Color fundus image.
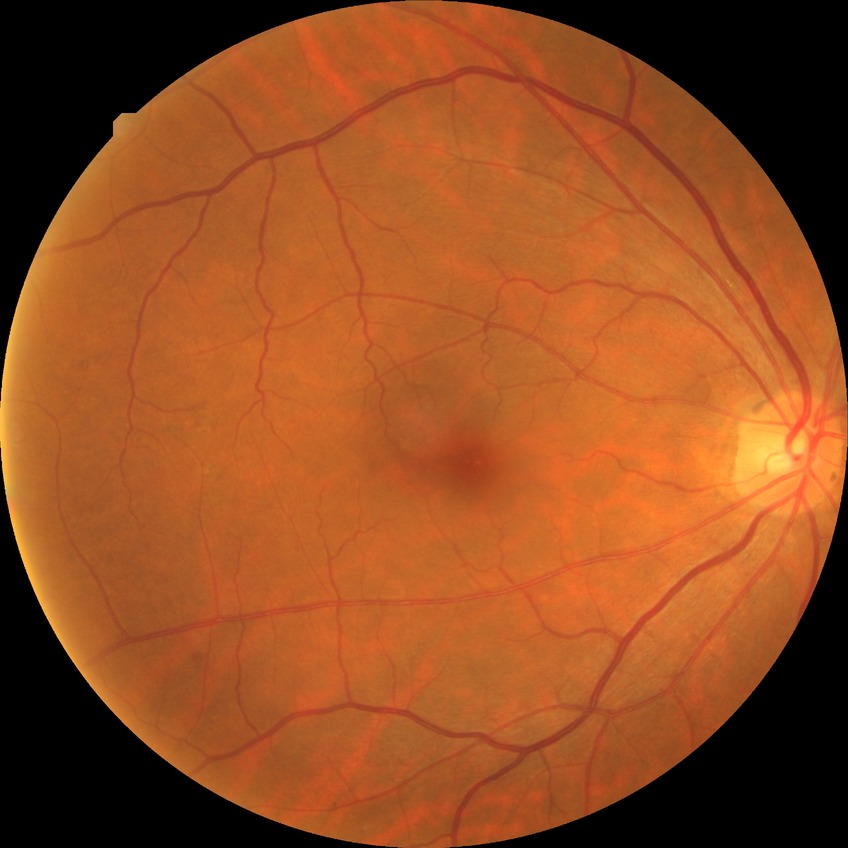 Findings:
* modified Davis grade — SDR